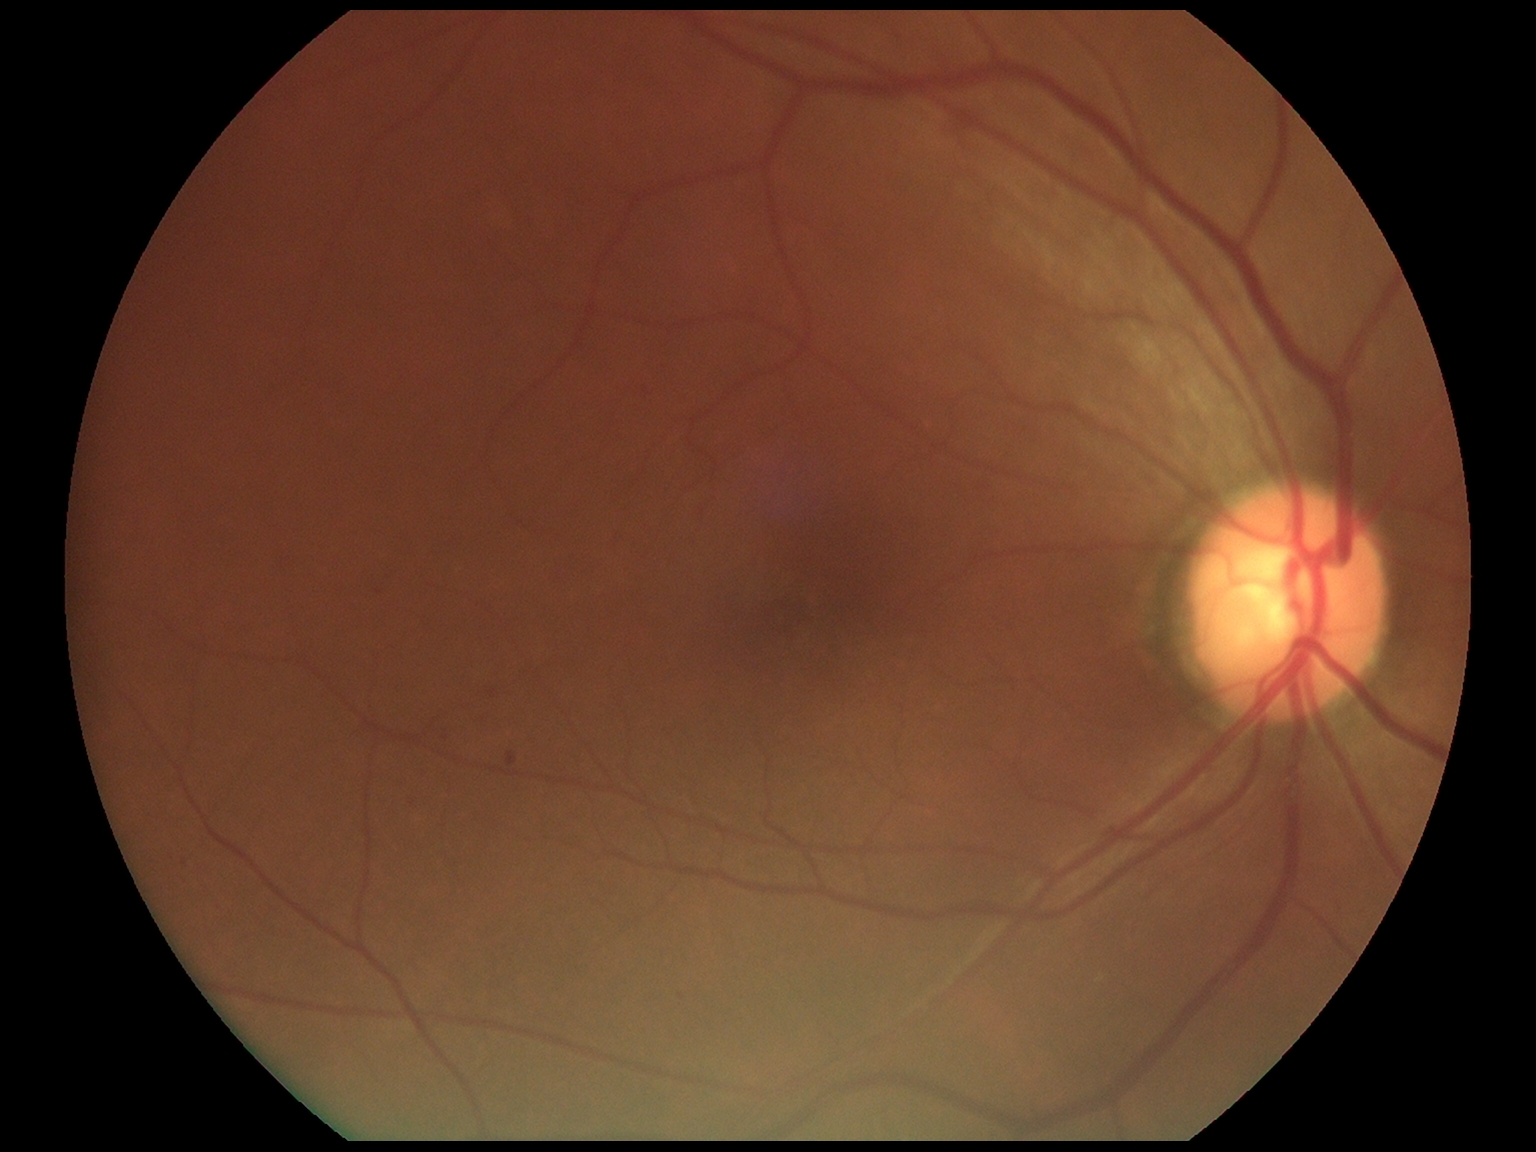

DR class = non-proliferative diabetic retinopathy, DR grade = 1 (mild NPDR) — presence of microaneurysms only.